Retinal fundus photograph · 45-degree field of view: 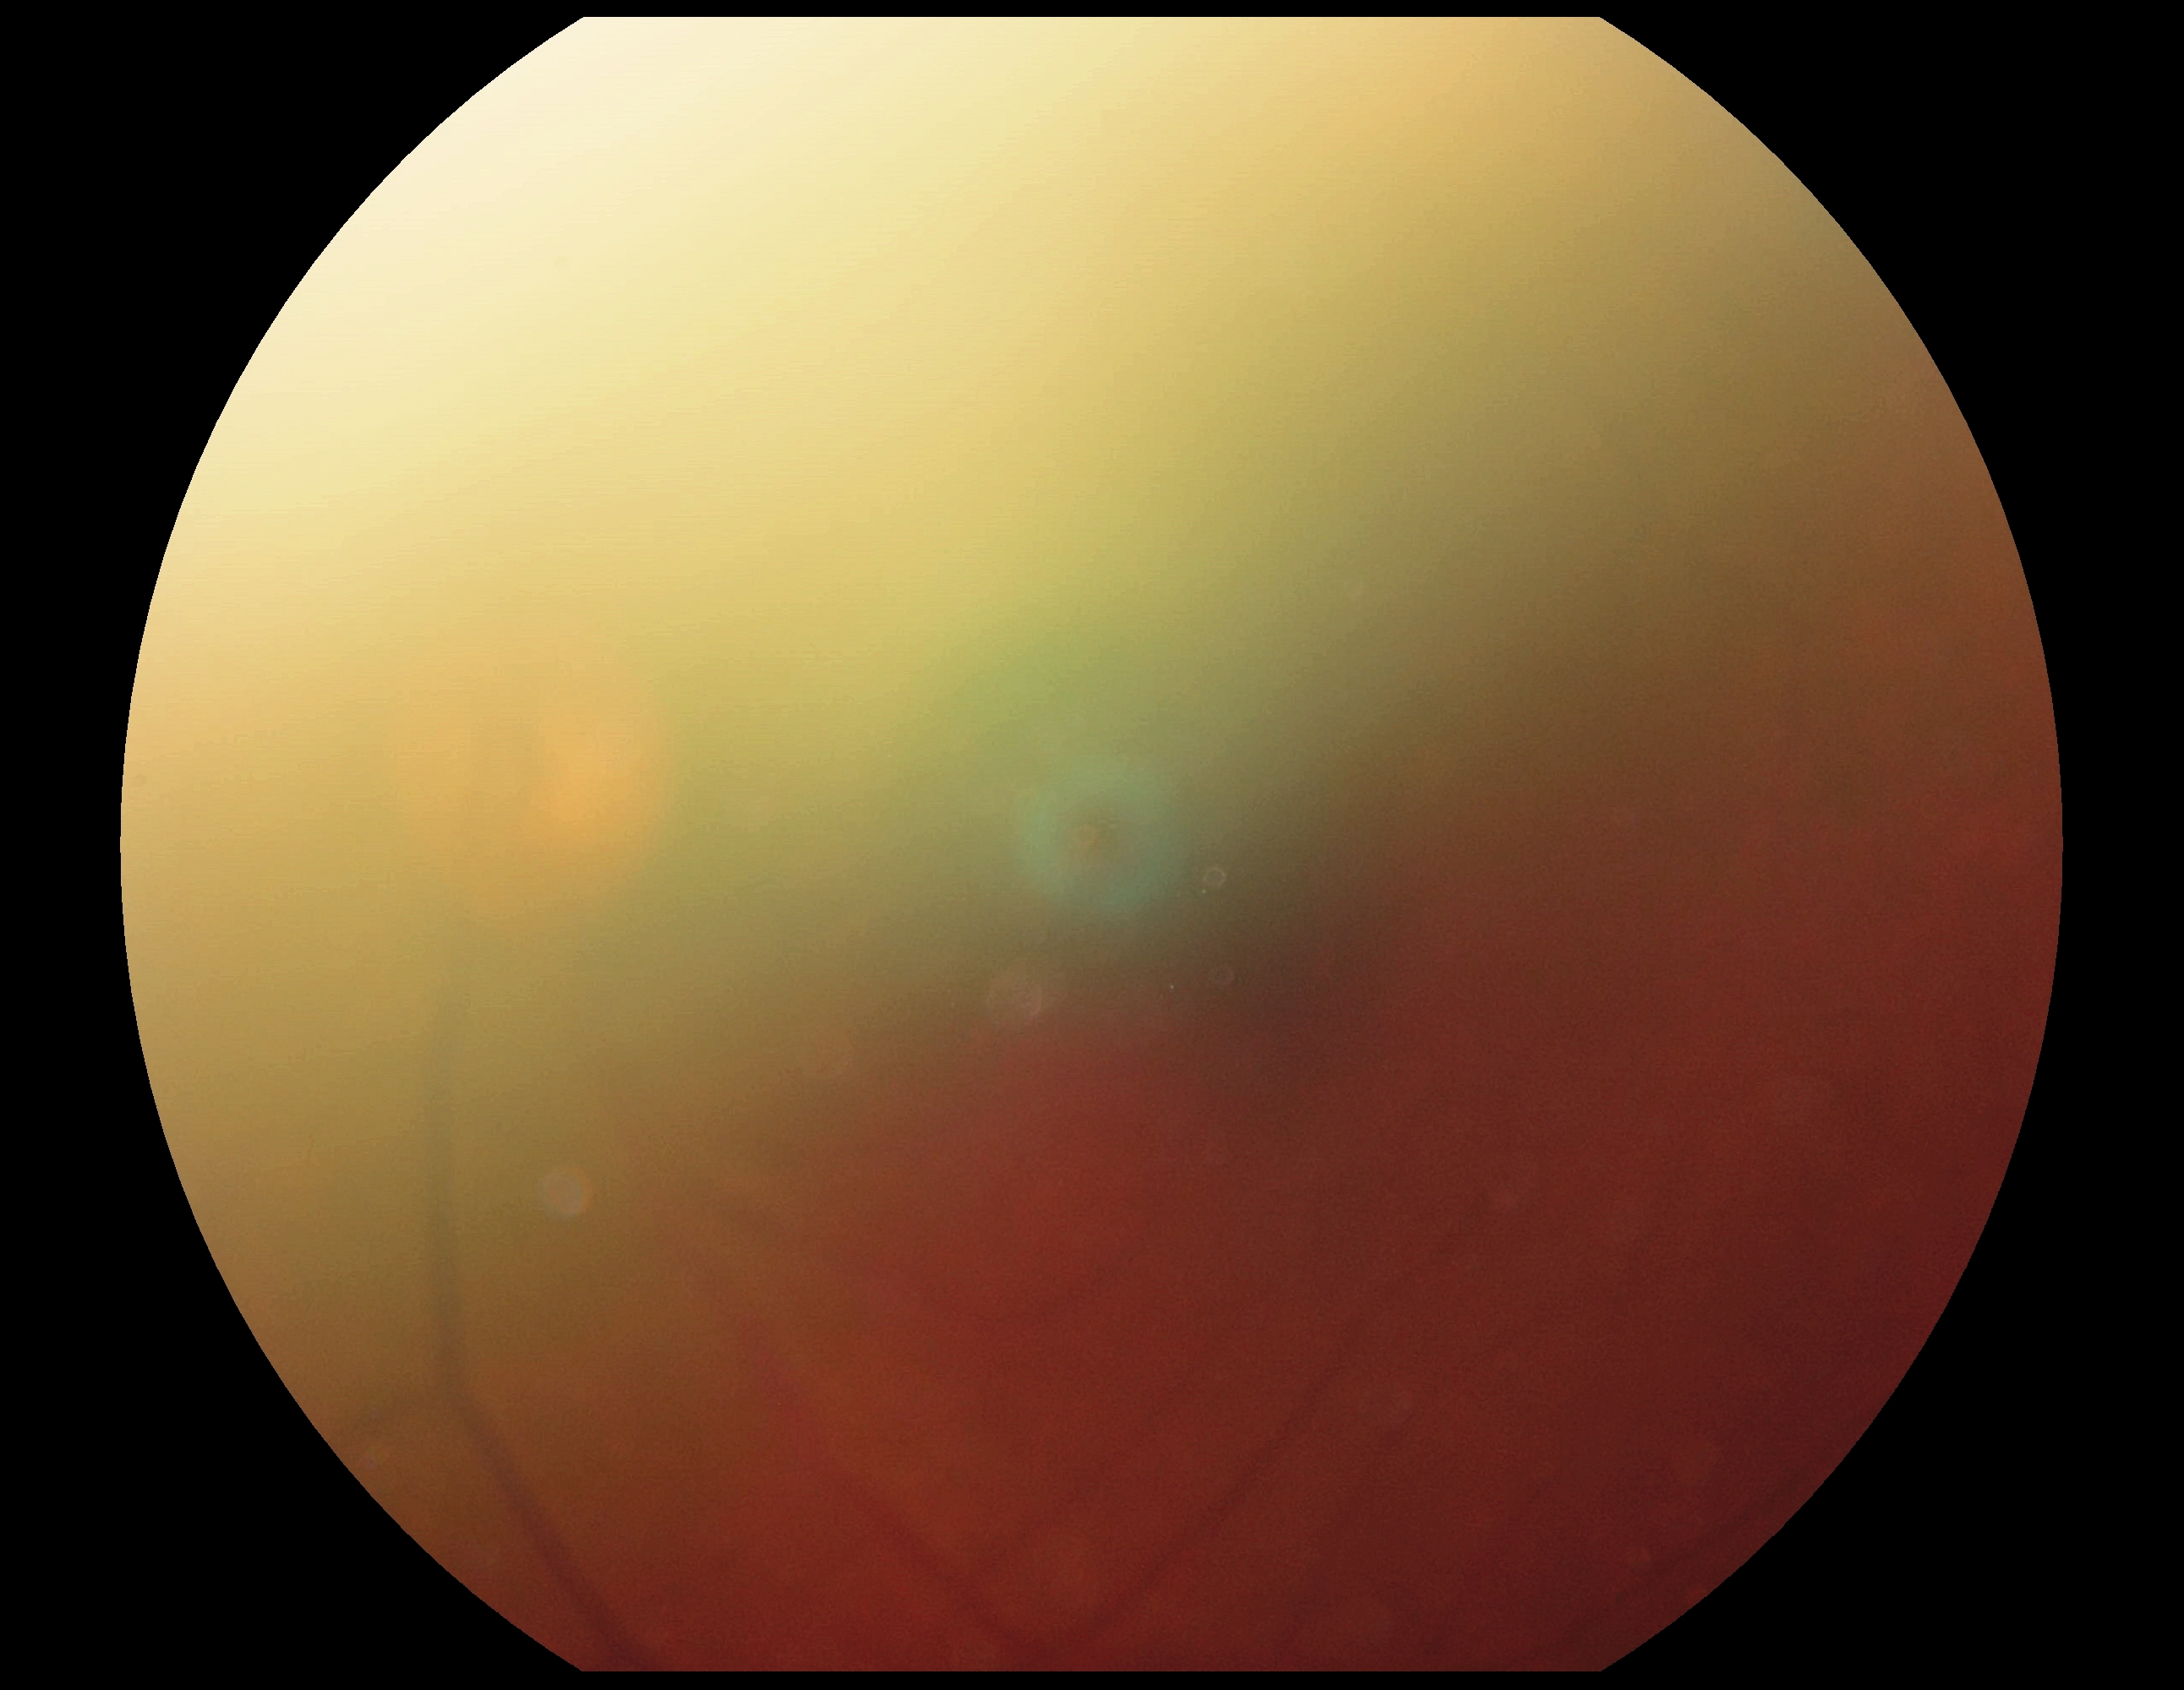 DR severity: ungradable due to poor image quality; image quality: insufficient.